Nonmydriatic fundus photograph.
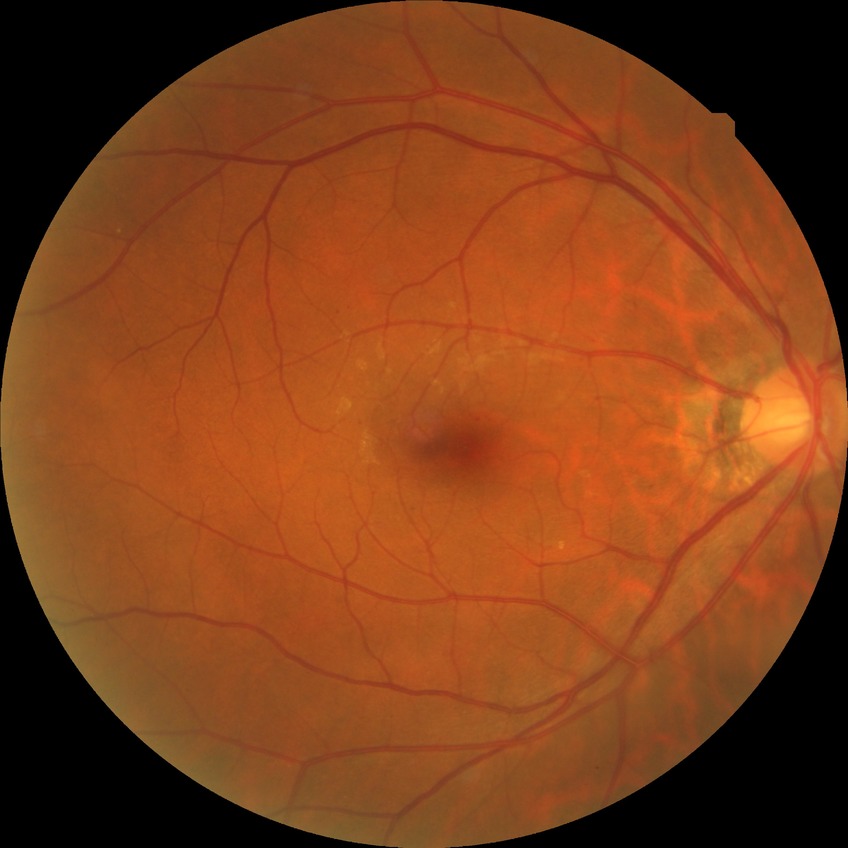
Diabetic retinopathy (DR): no diabetic retinopathy (NDR).